Posterior pole view · dilated-pupil acquisition
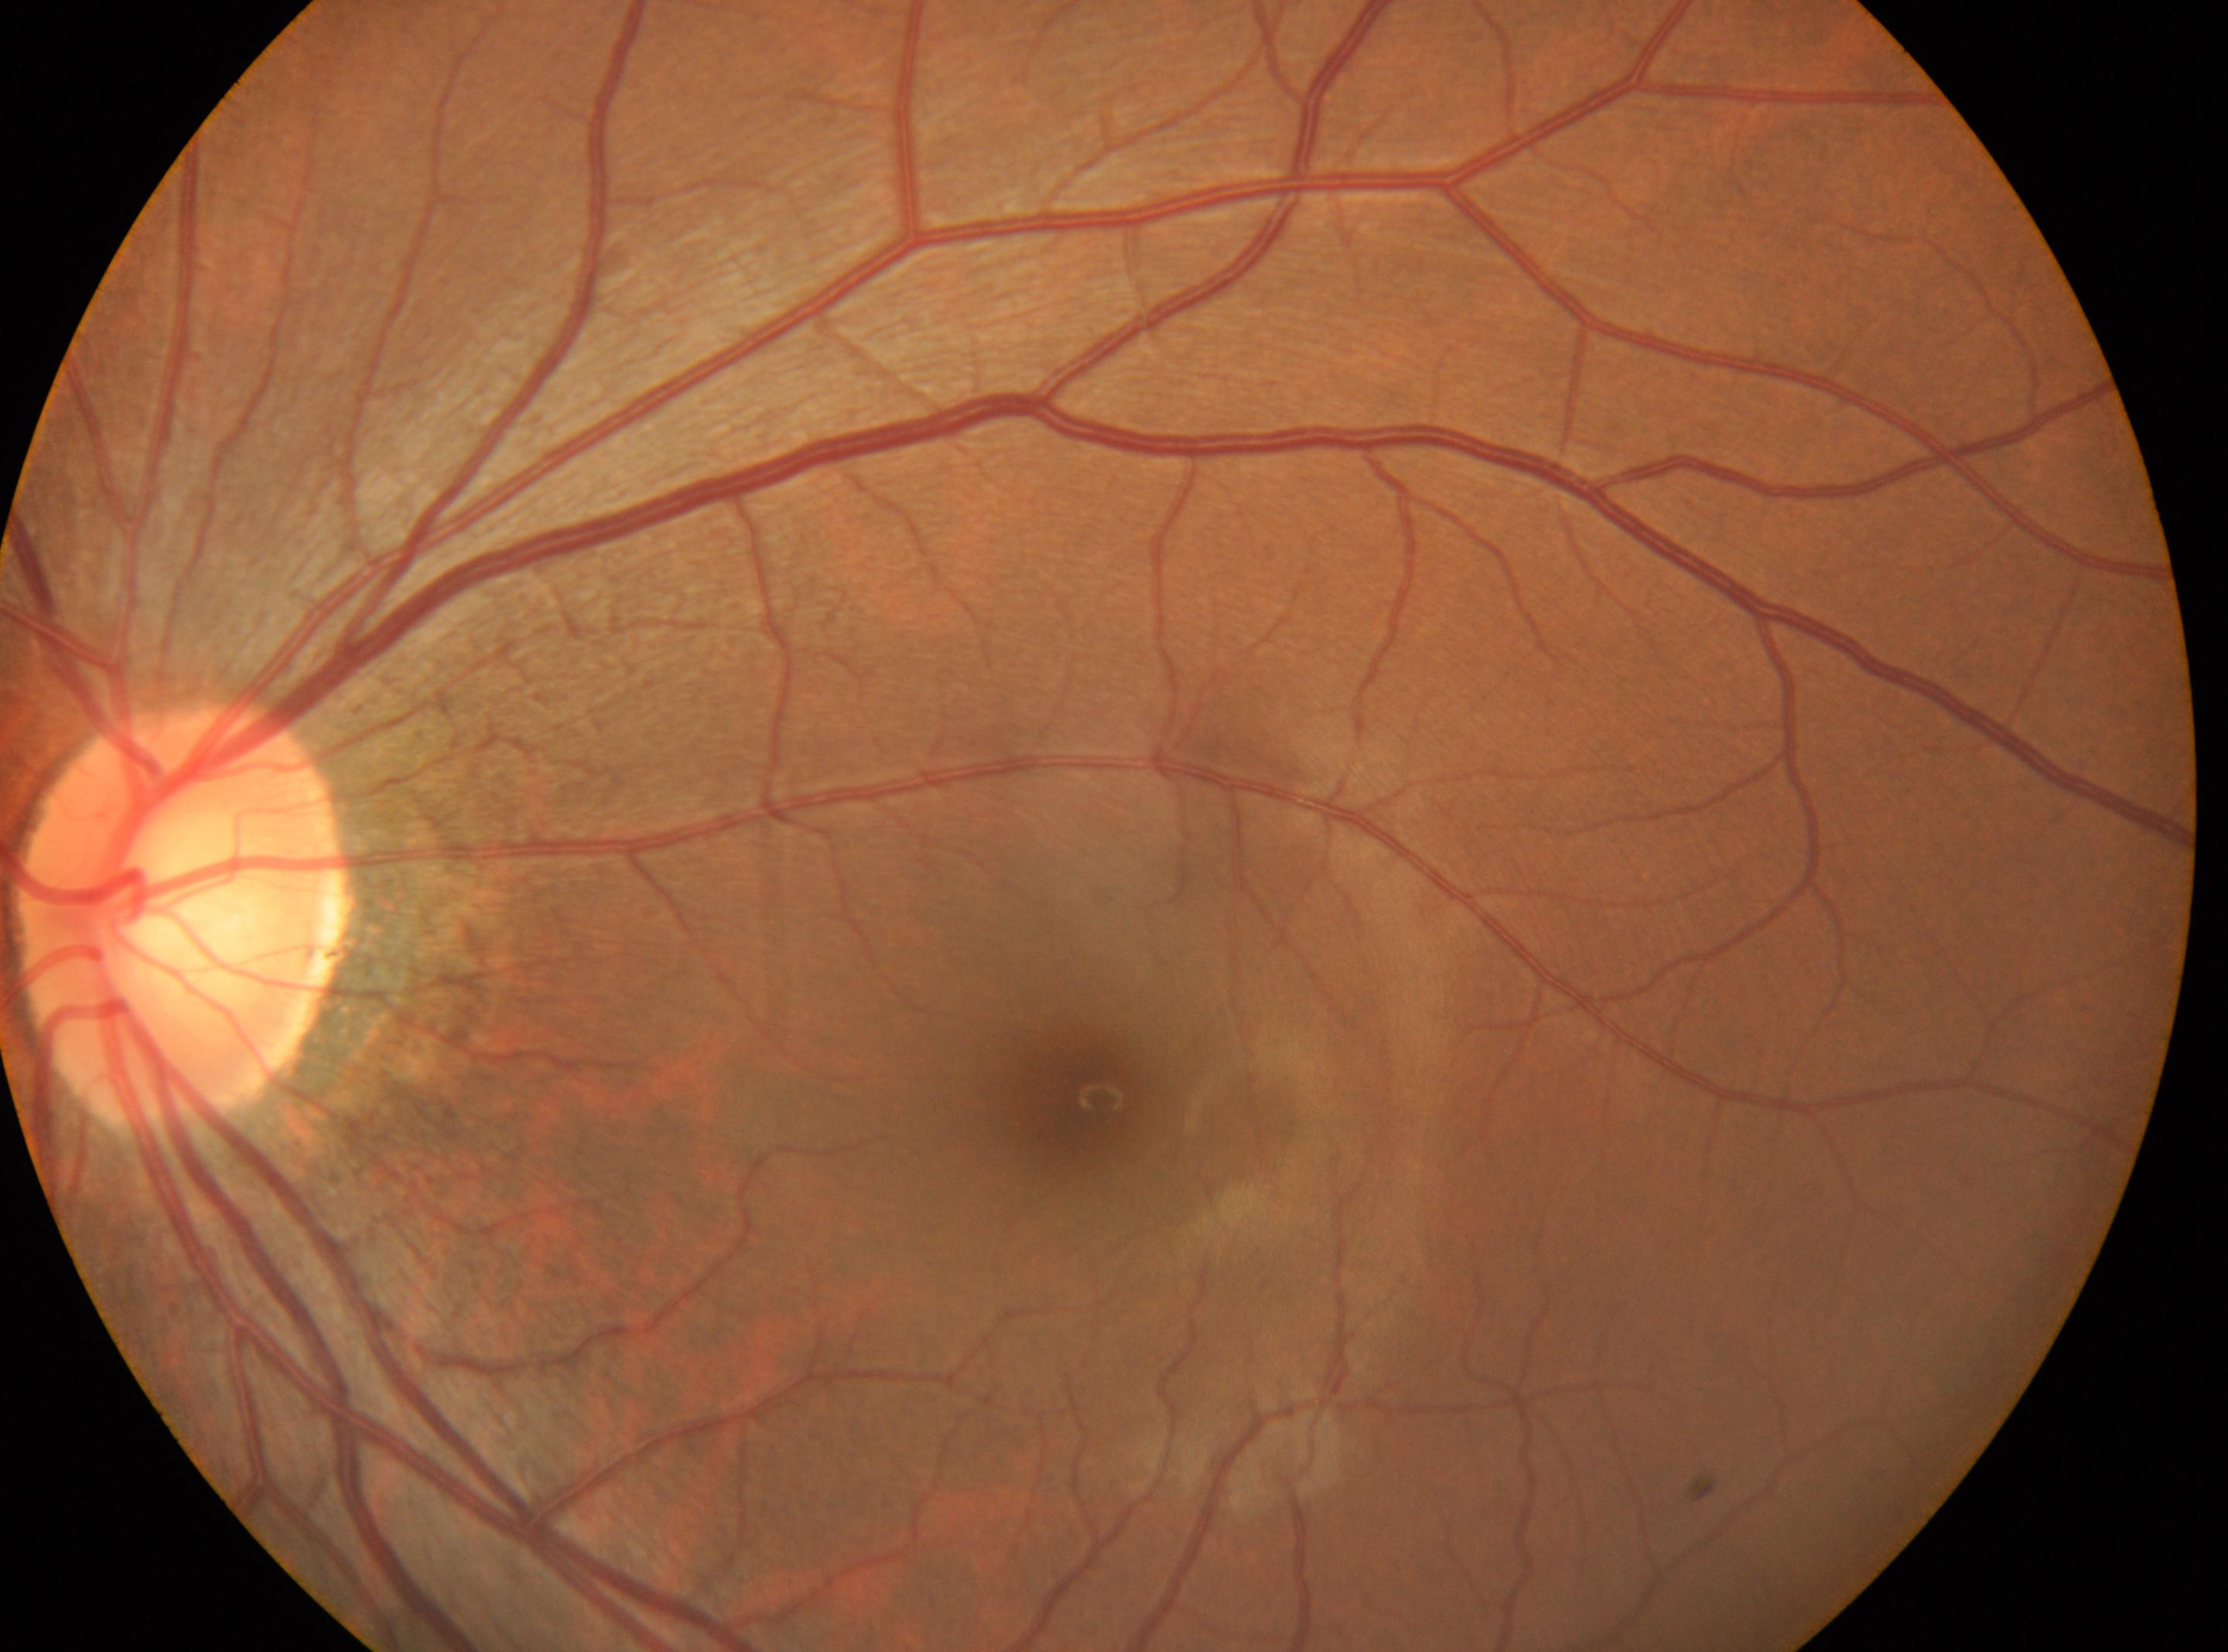

* DR impression — No diabetic retinal disease findings
* the optic disc — 180, 916
* laterality — left eye
* DR severity — 0
* fovea center — 1086, 1098